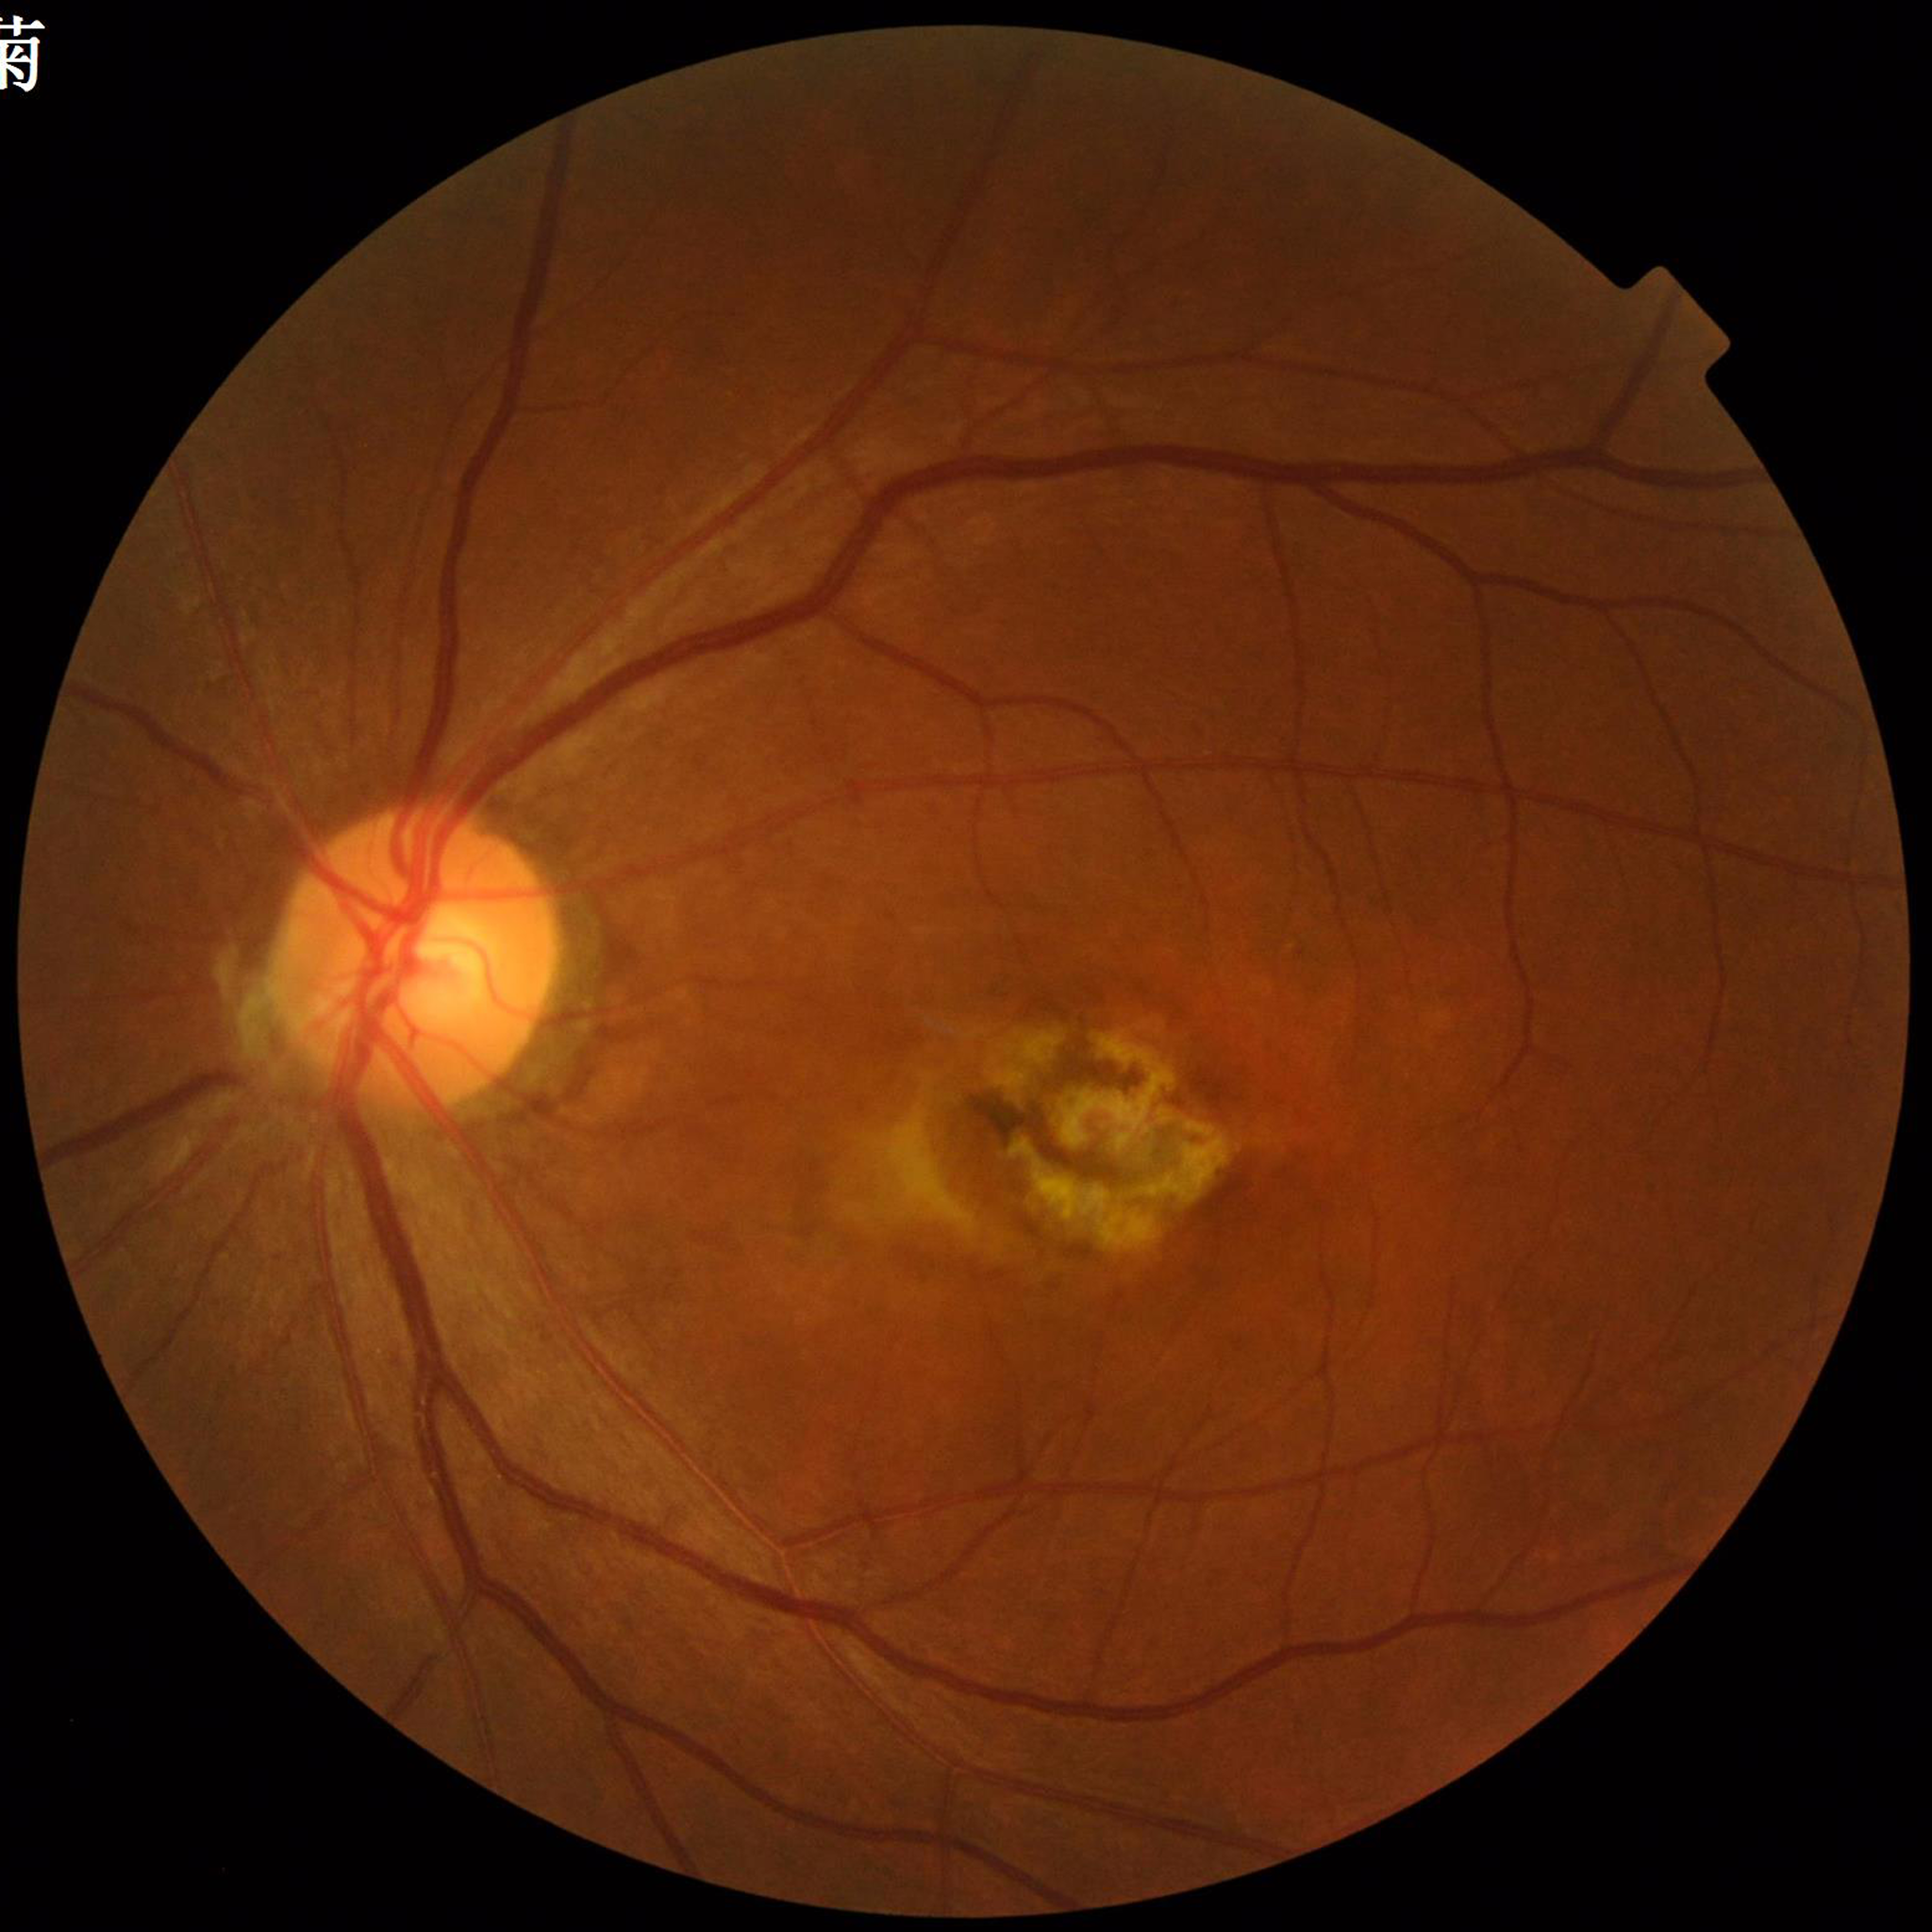 Patient diagnosed with AMD.